1960 by 1897 pixels · CFP · 45° FOV: 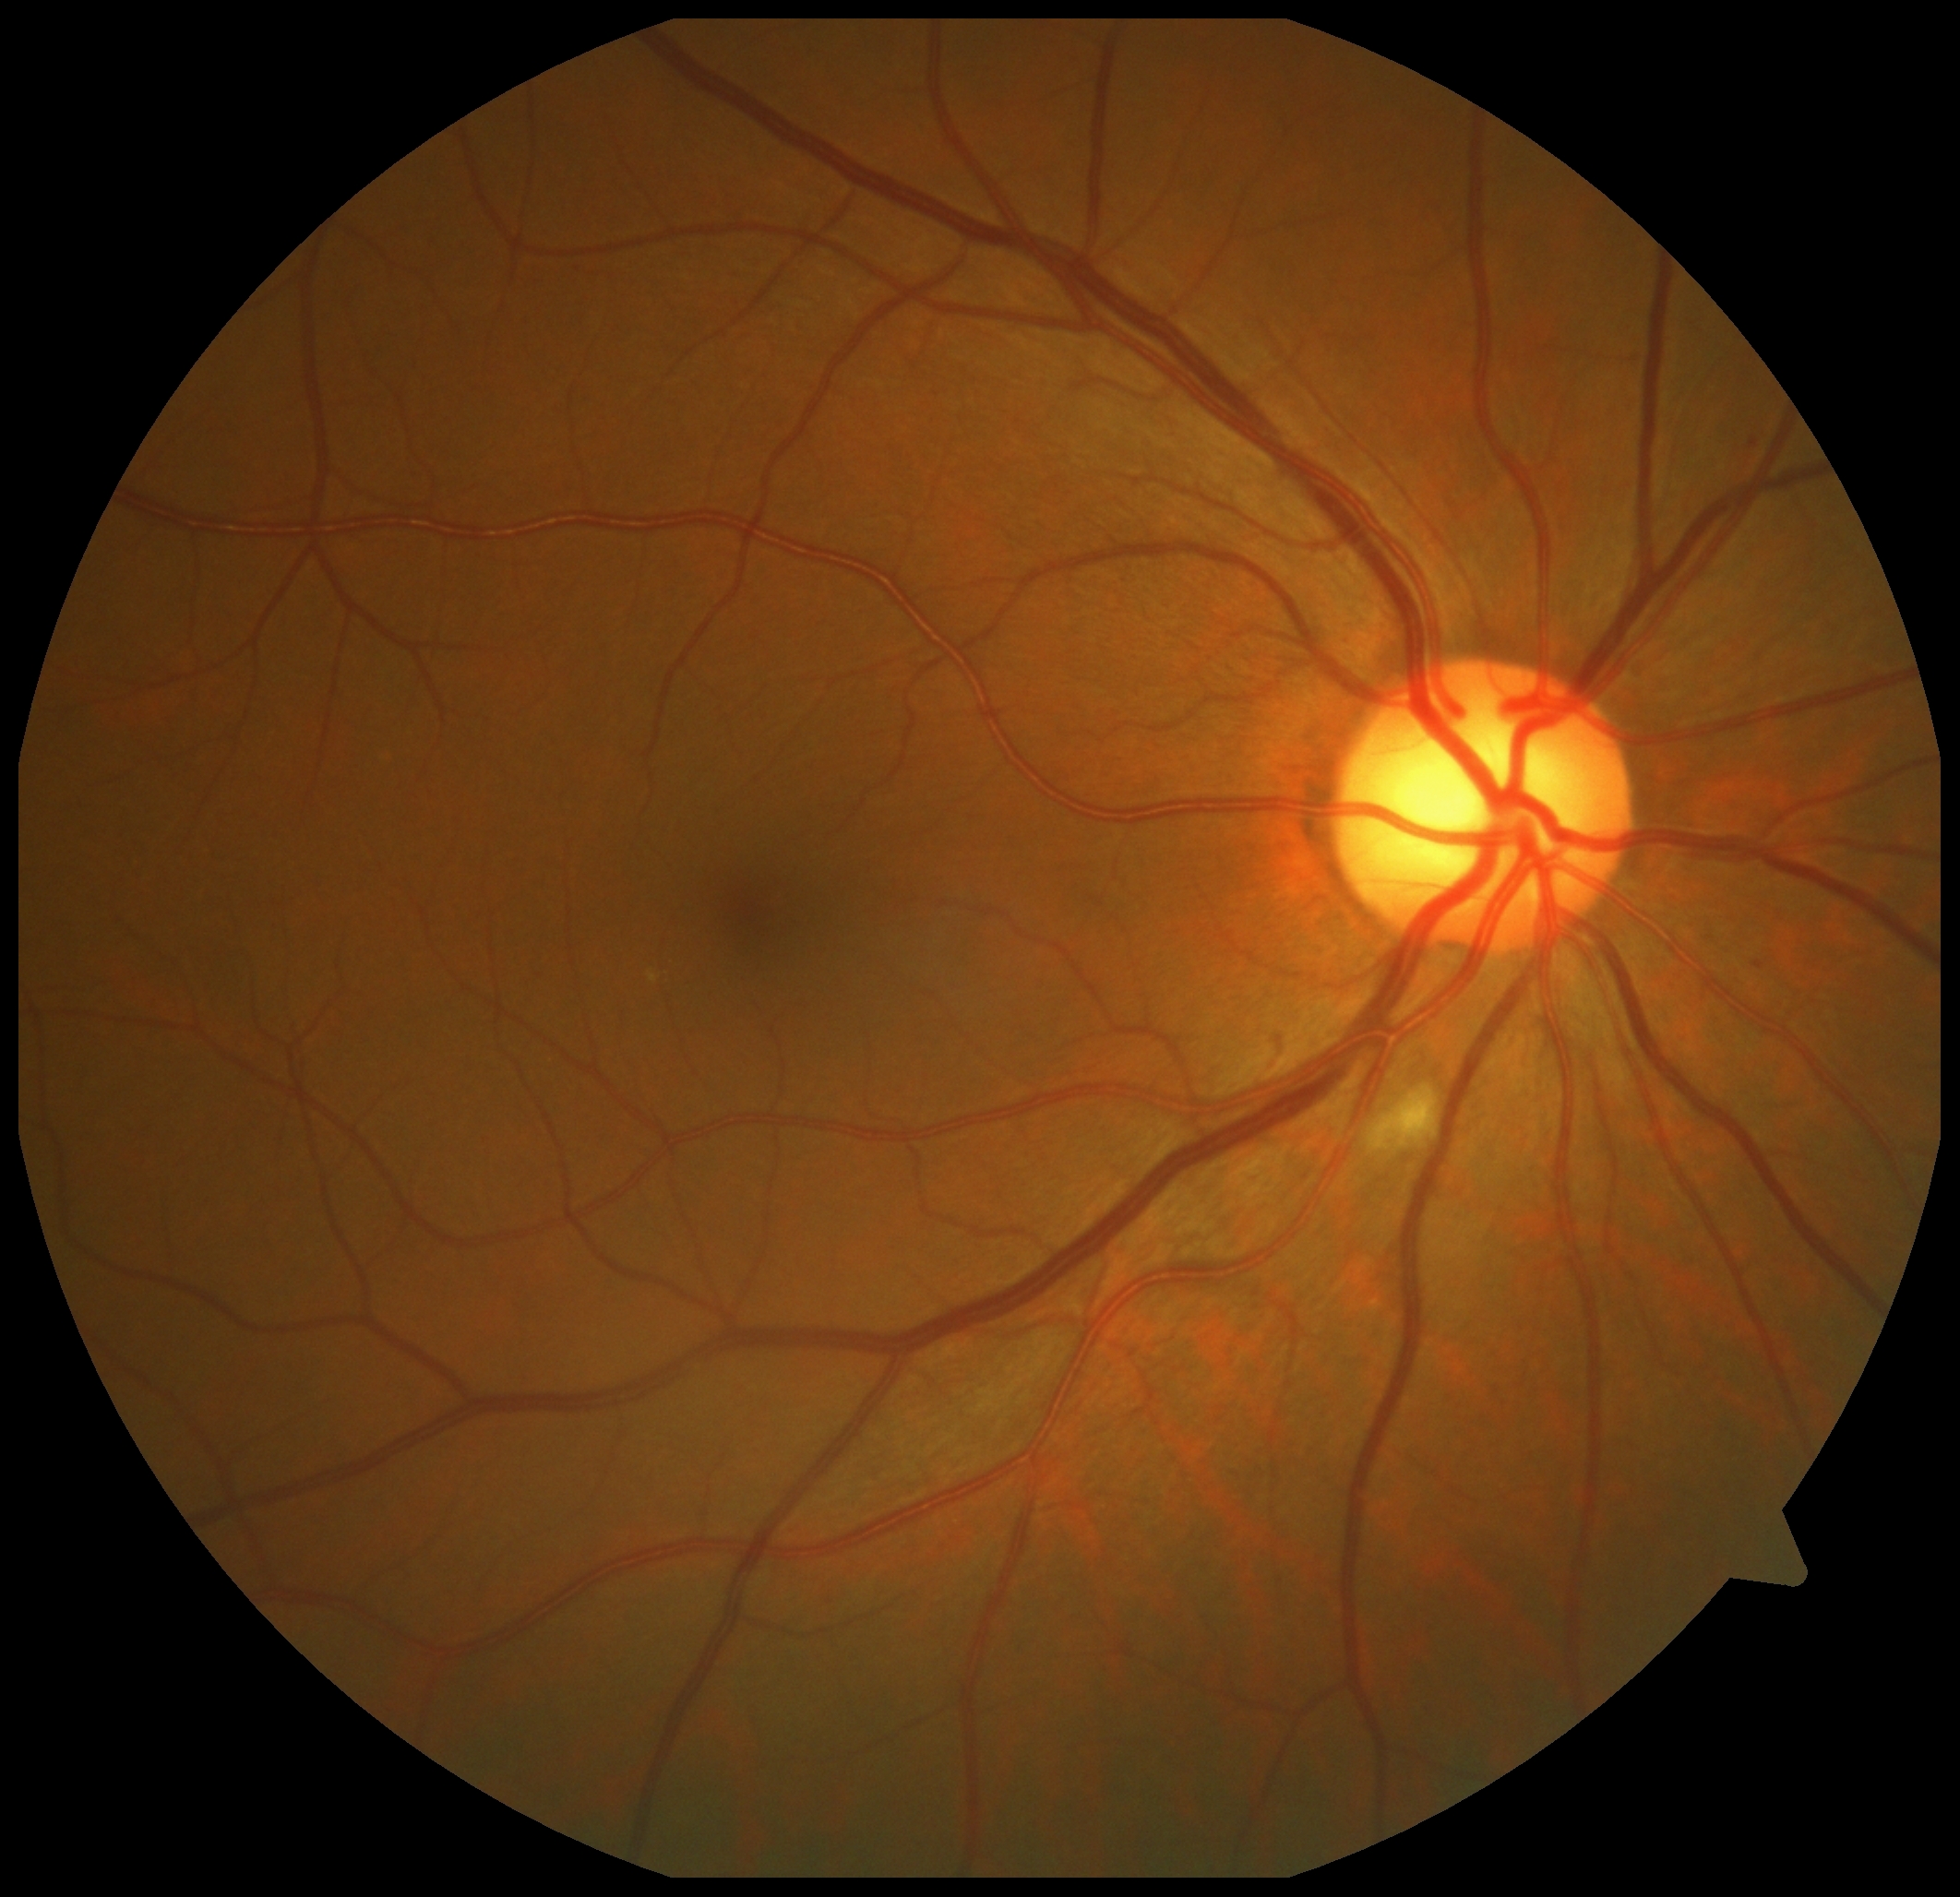
{"dr_grade":2,"lesions":{"ma":[[1751,962,1763,968],[1750,438,1759,447]],"ex":null,"he":null,"se":[[1380,1088,1436,1148]]}}